CFP
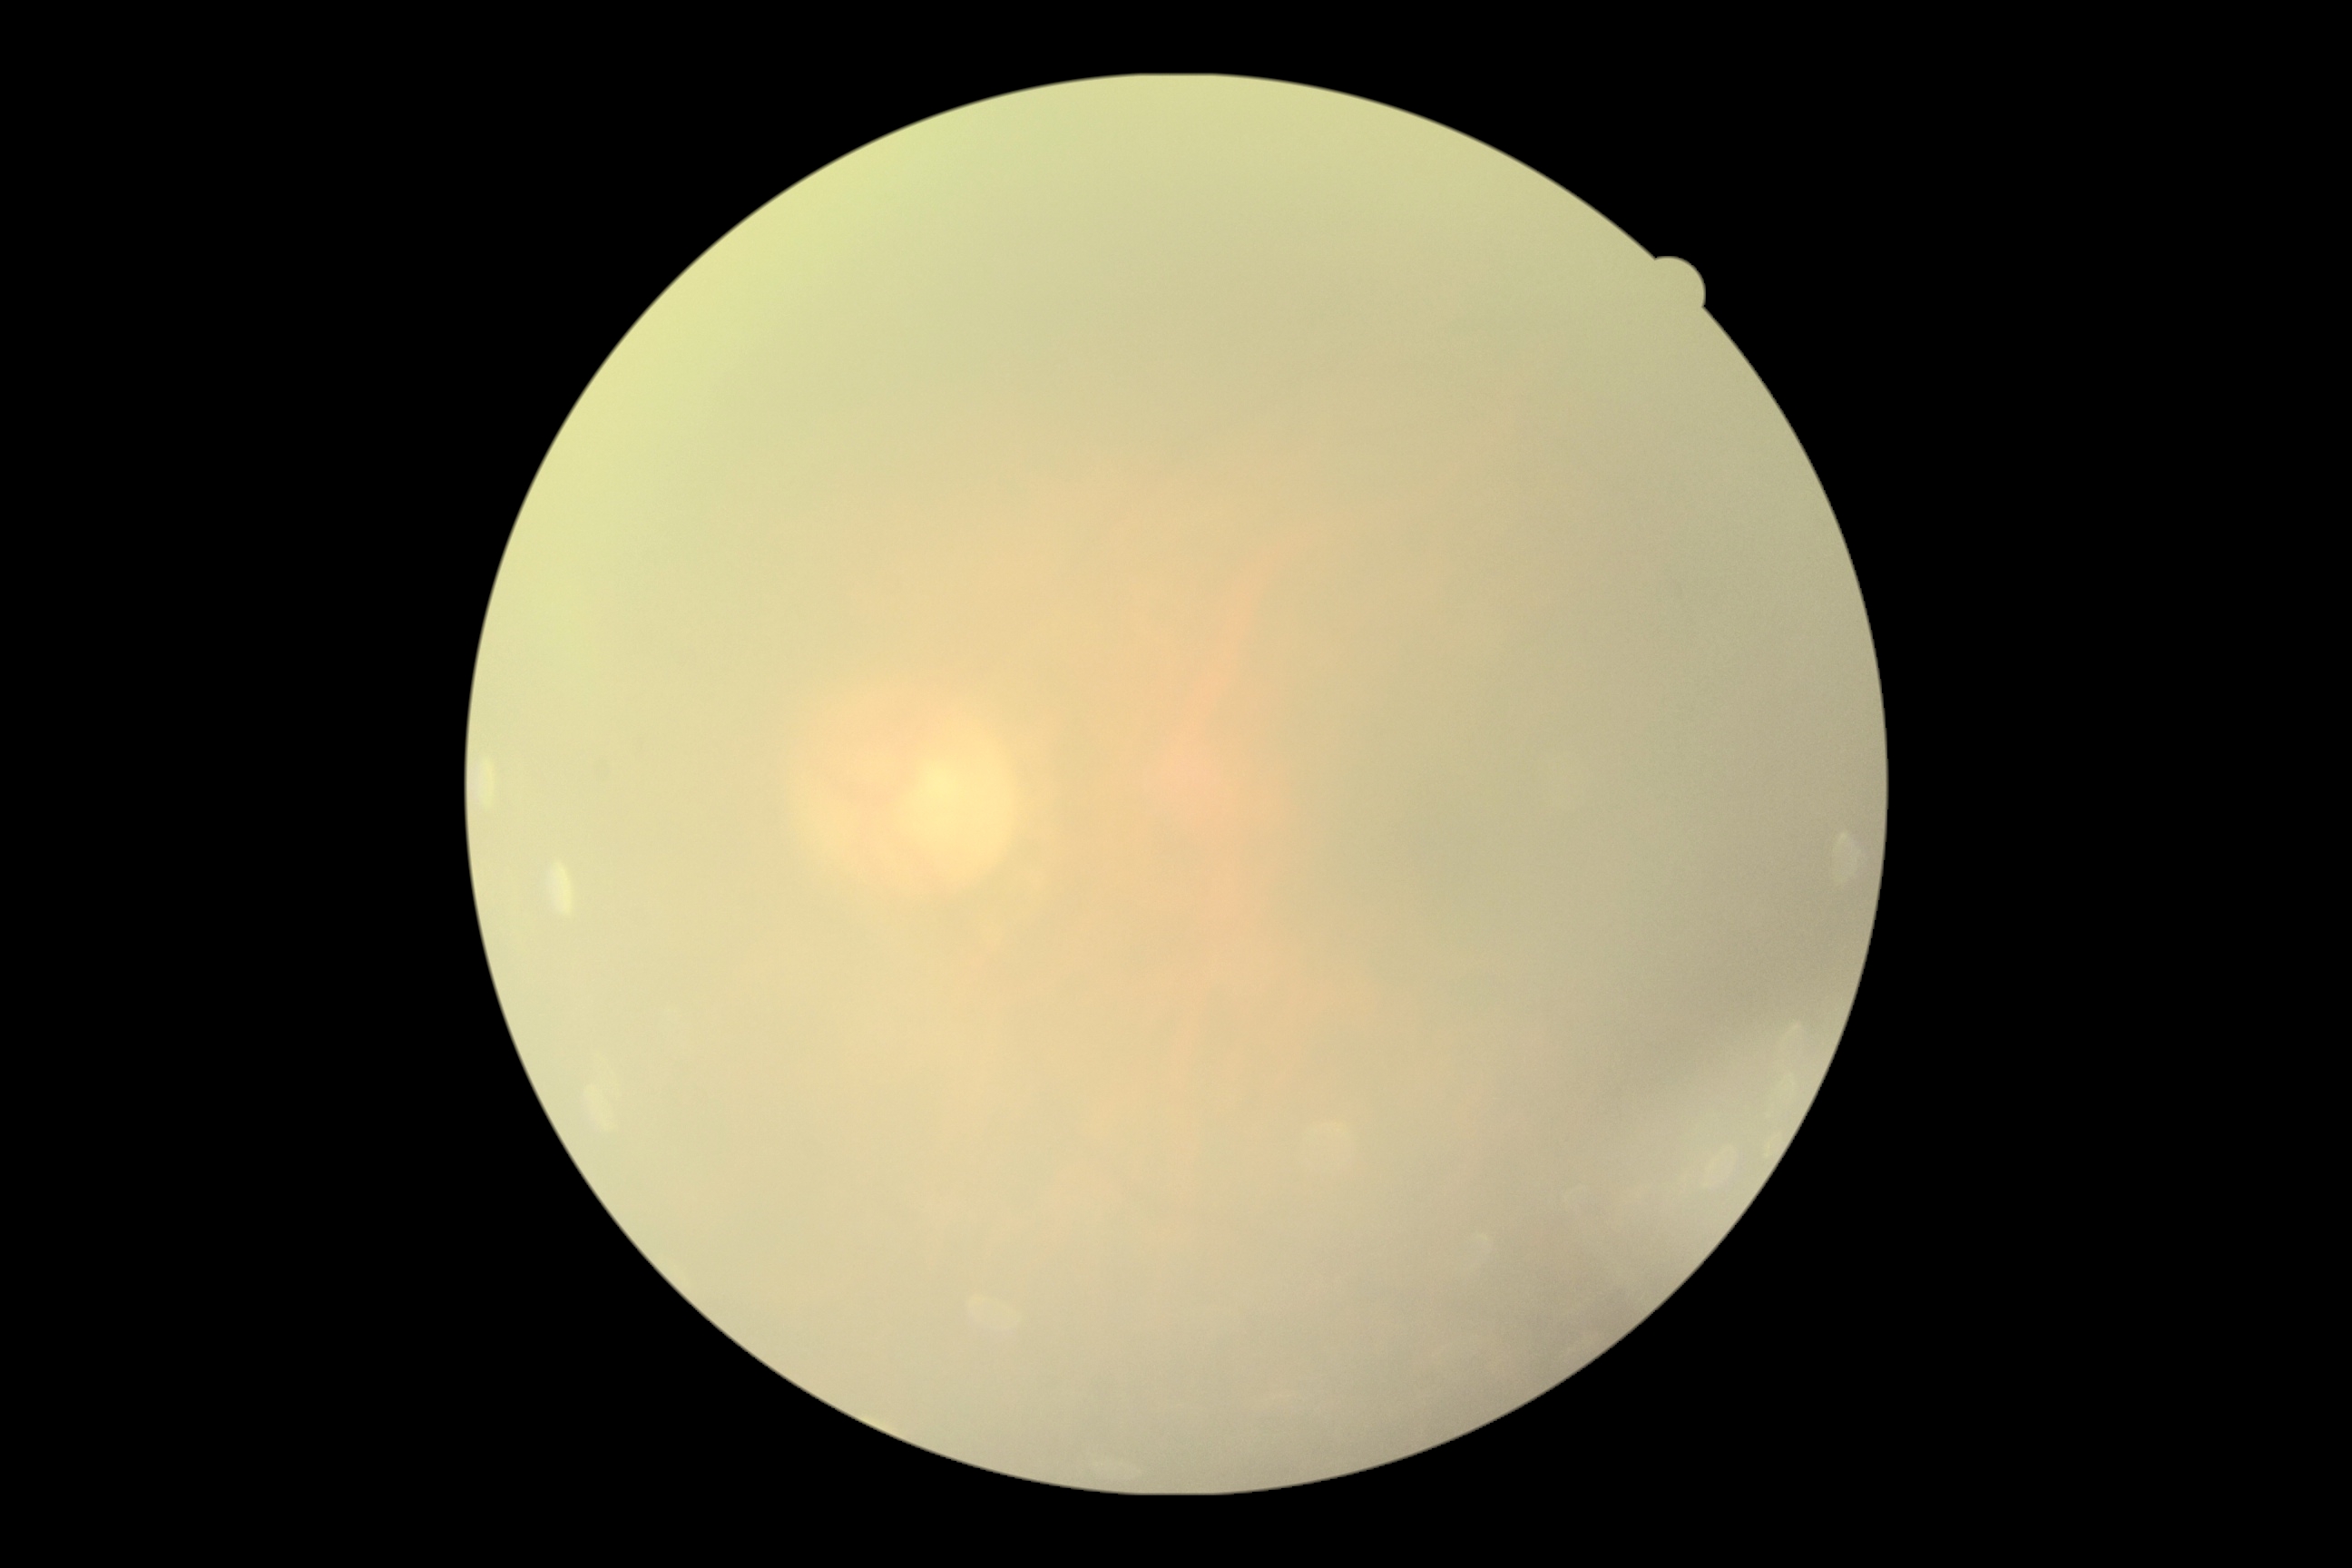
Annotations:
* diabetic retinopathy — ungradable